45° FOV. 2352x1568px.
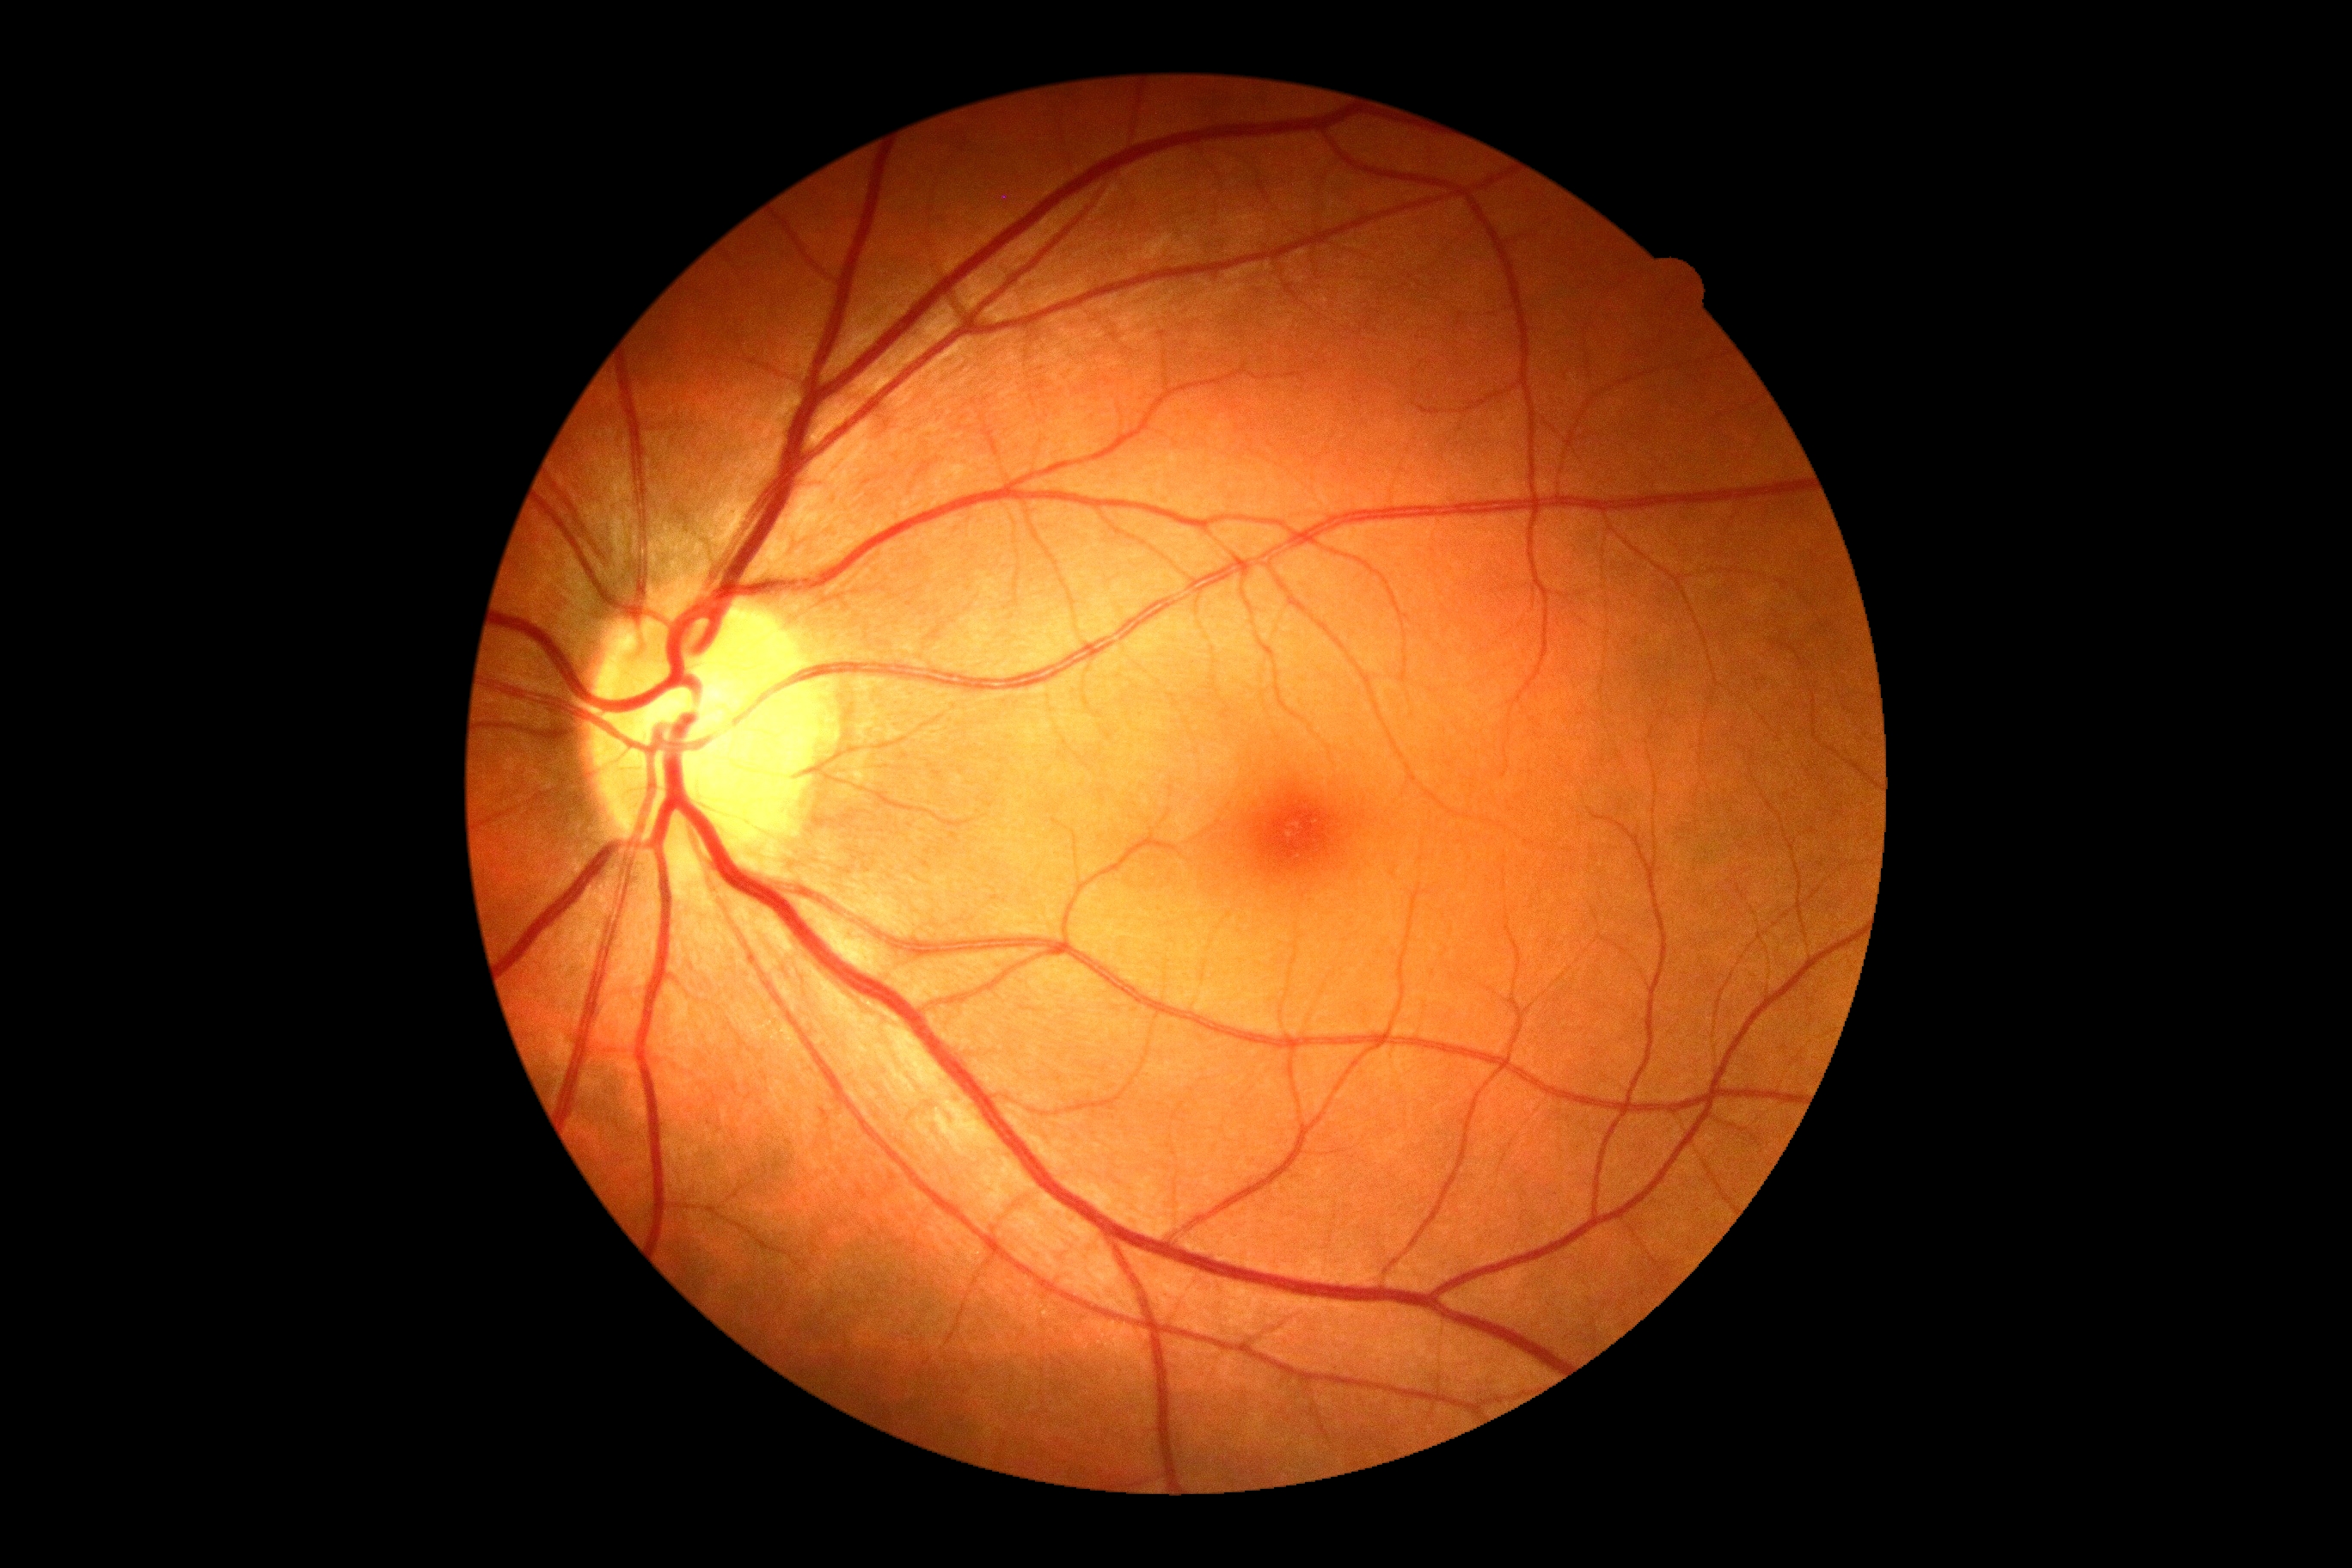
DR impression: no signs of DR, diabetic retinopathy (DR): grade 0 — no visible signs of diabetic retinopathy.